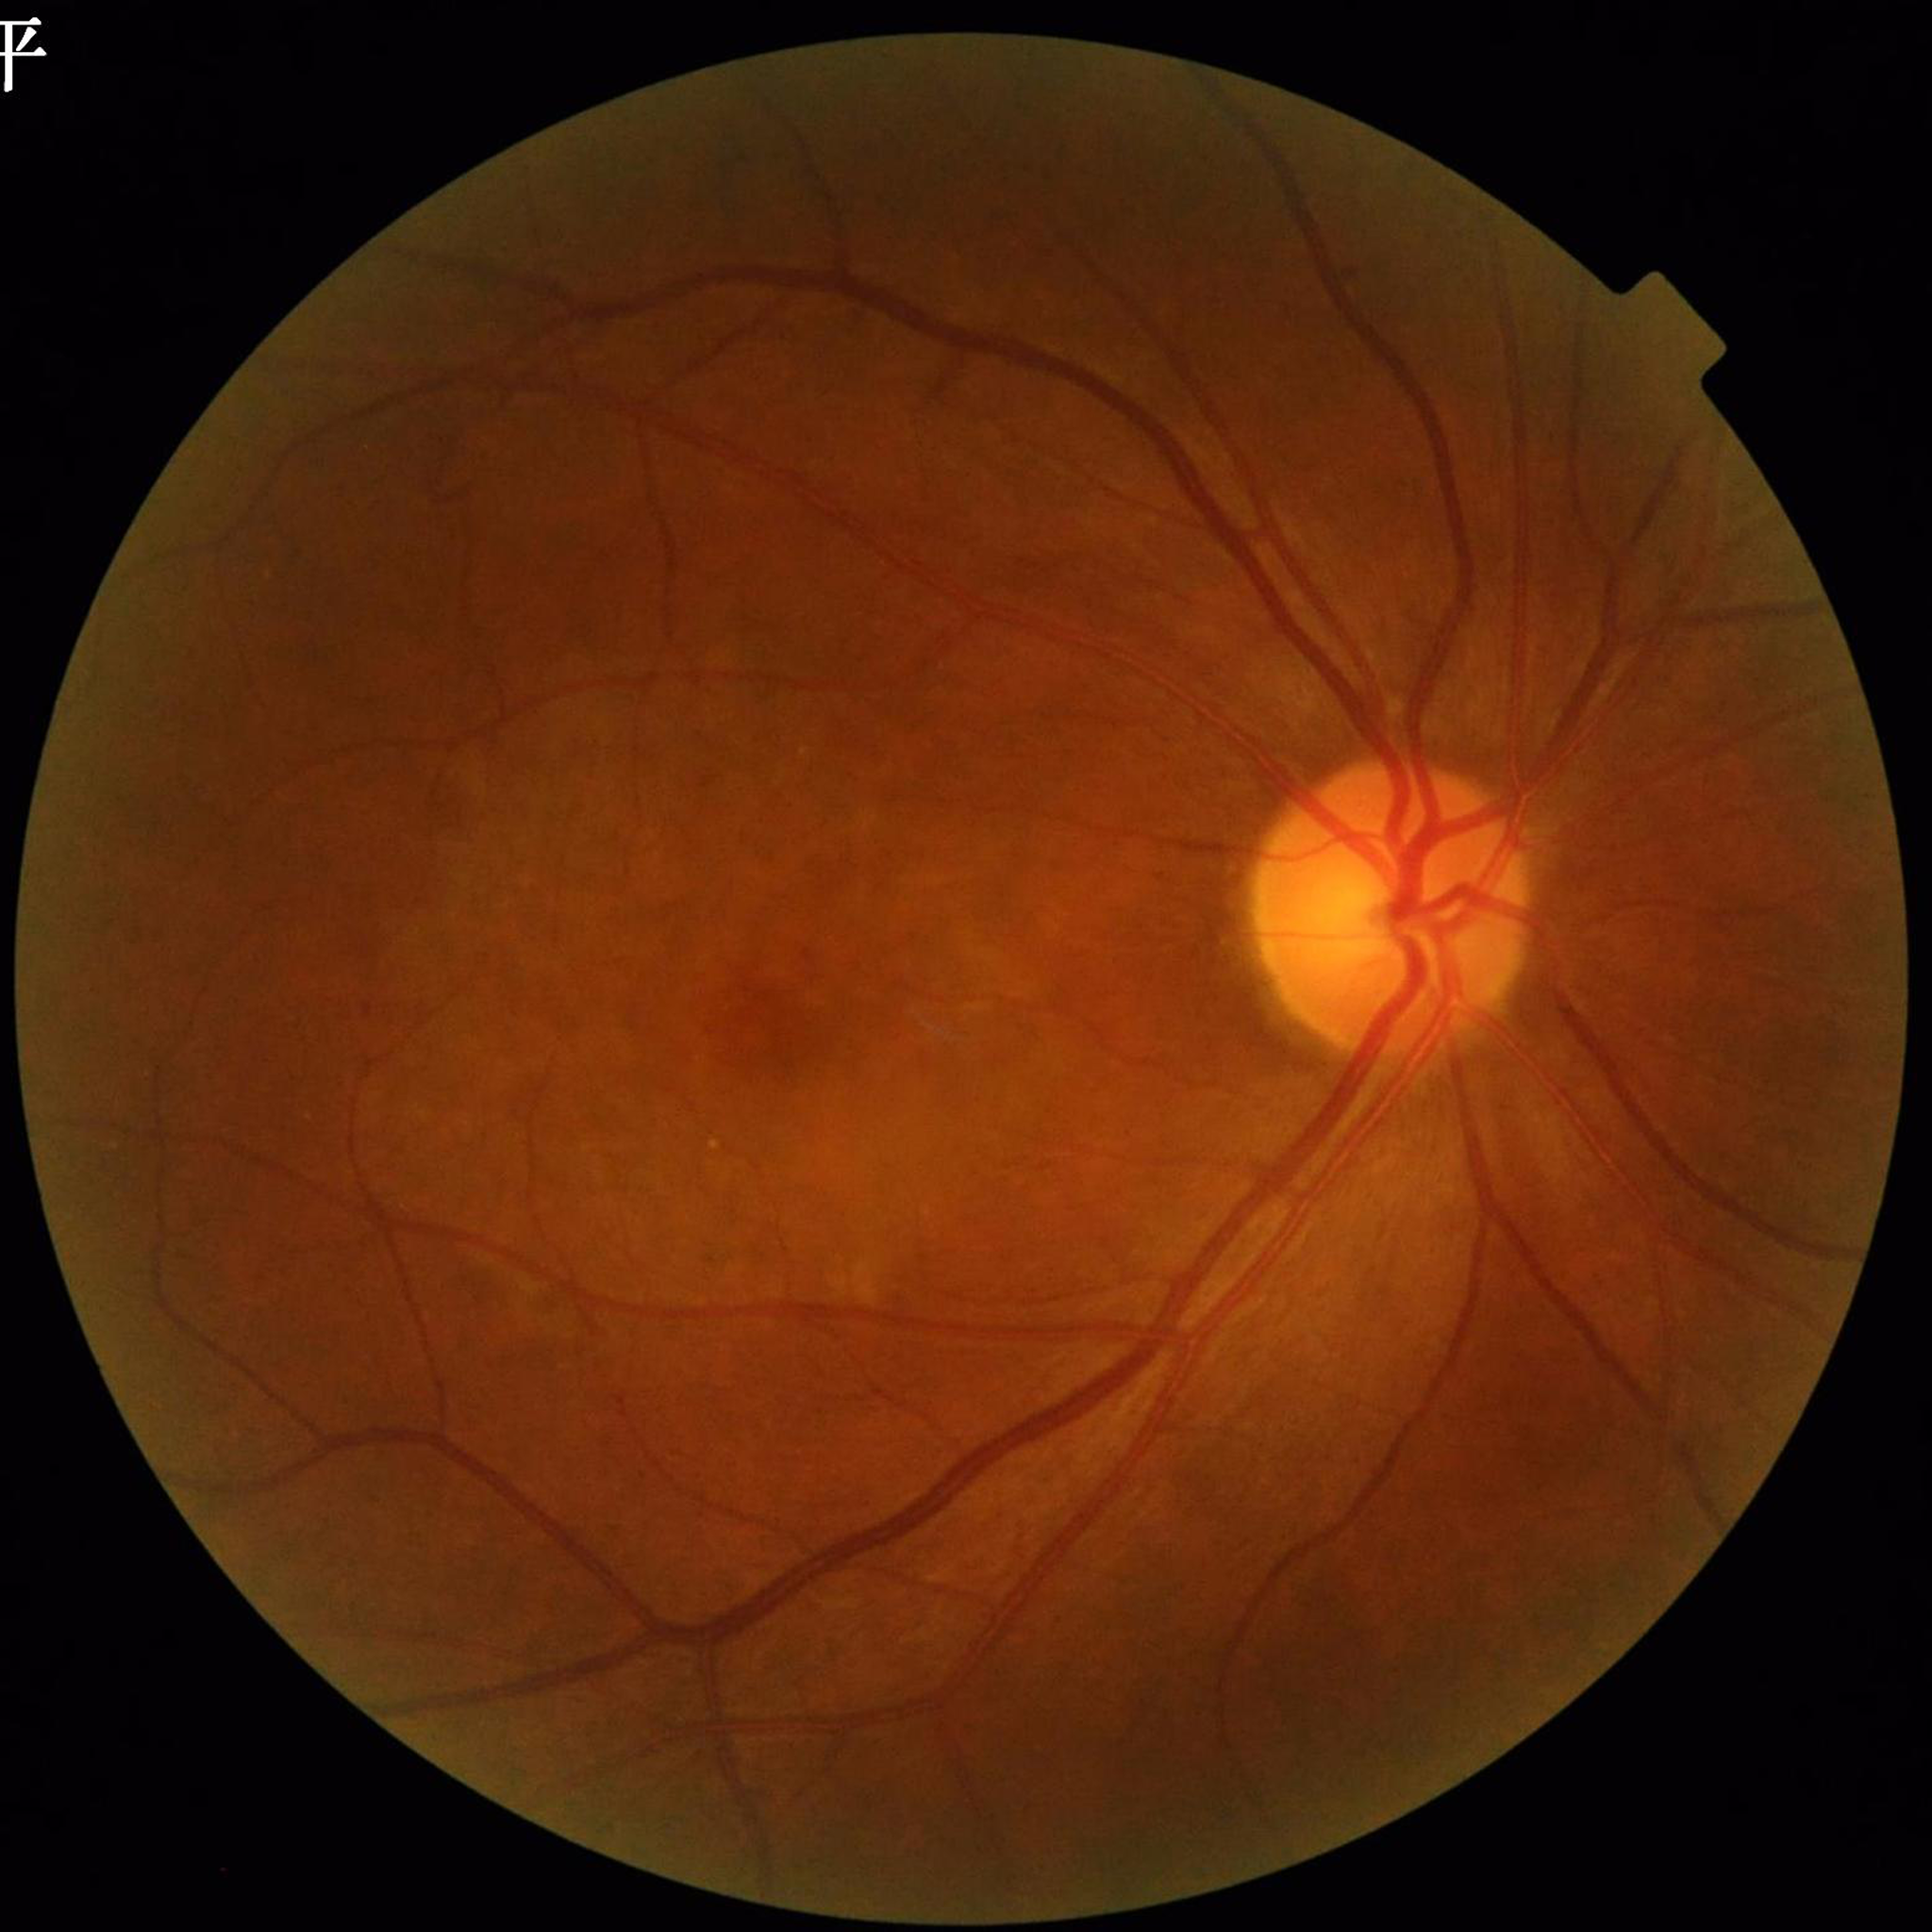

  image_quality: contrast adequate, no blur, illumination and color satisfactory
  diagnosis: DR